Refraction: sphere +1.5 D, cylinder -1.75 D, axis 102°; age 66 — 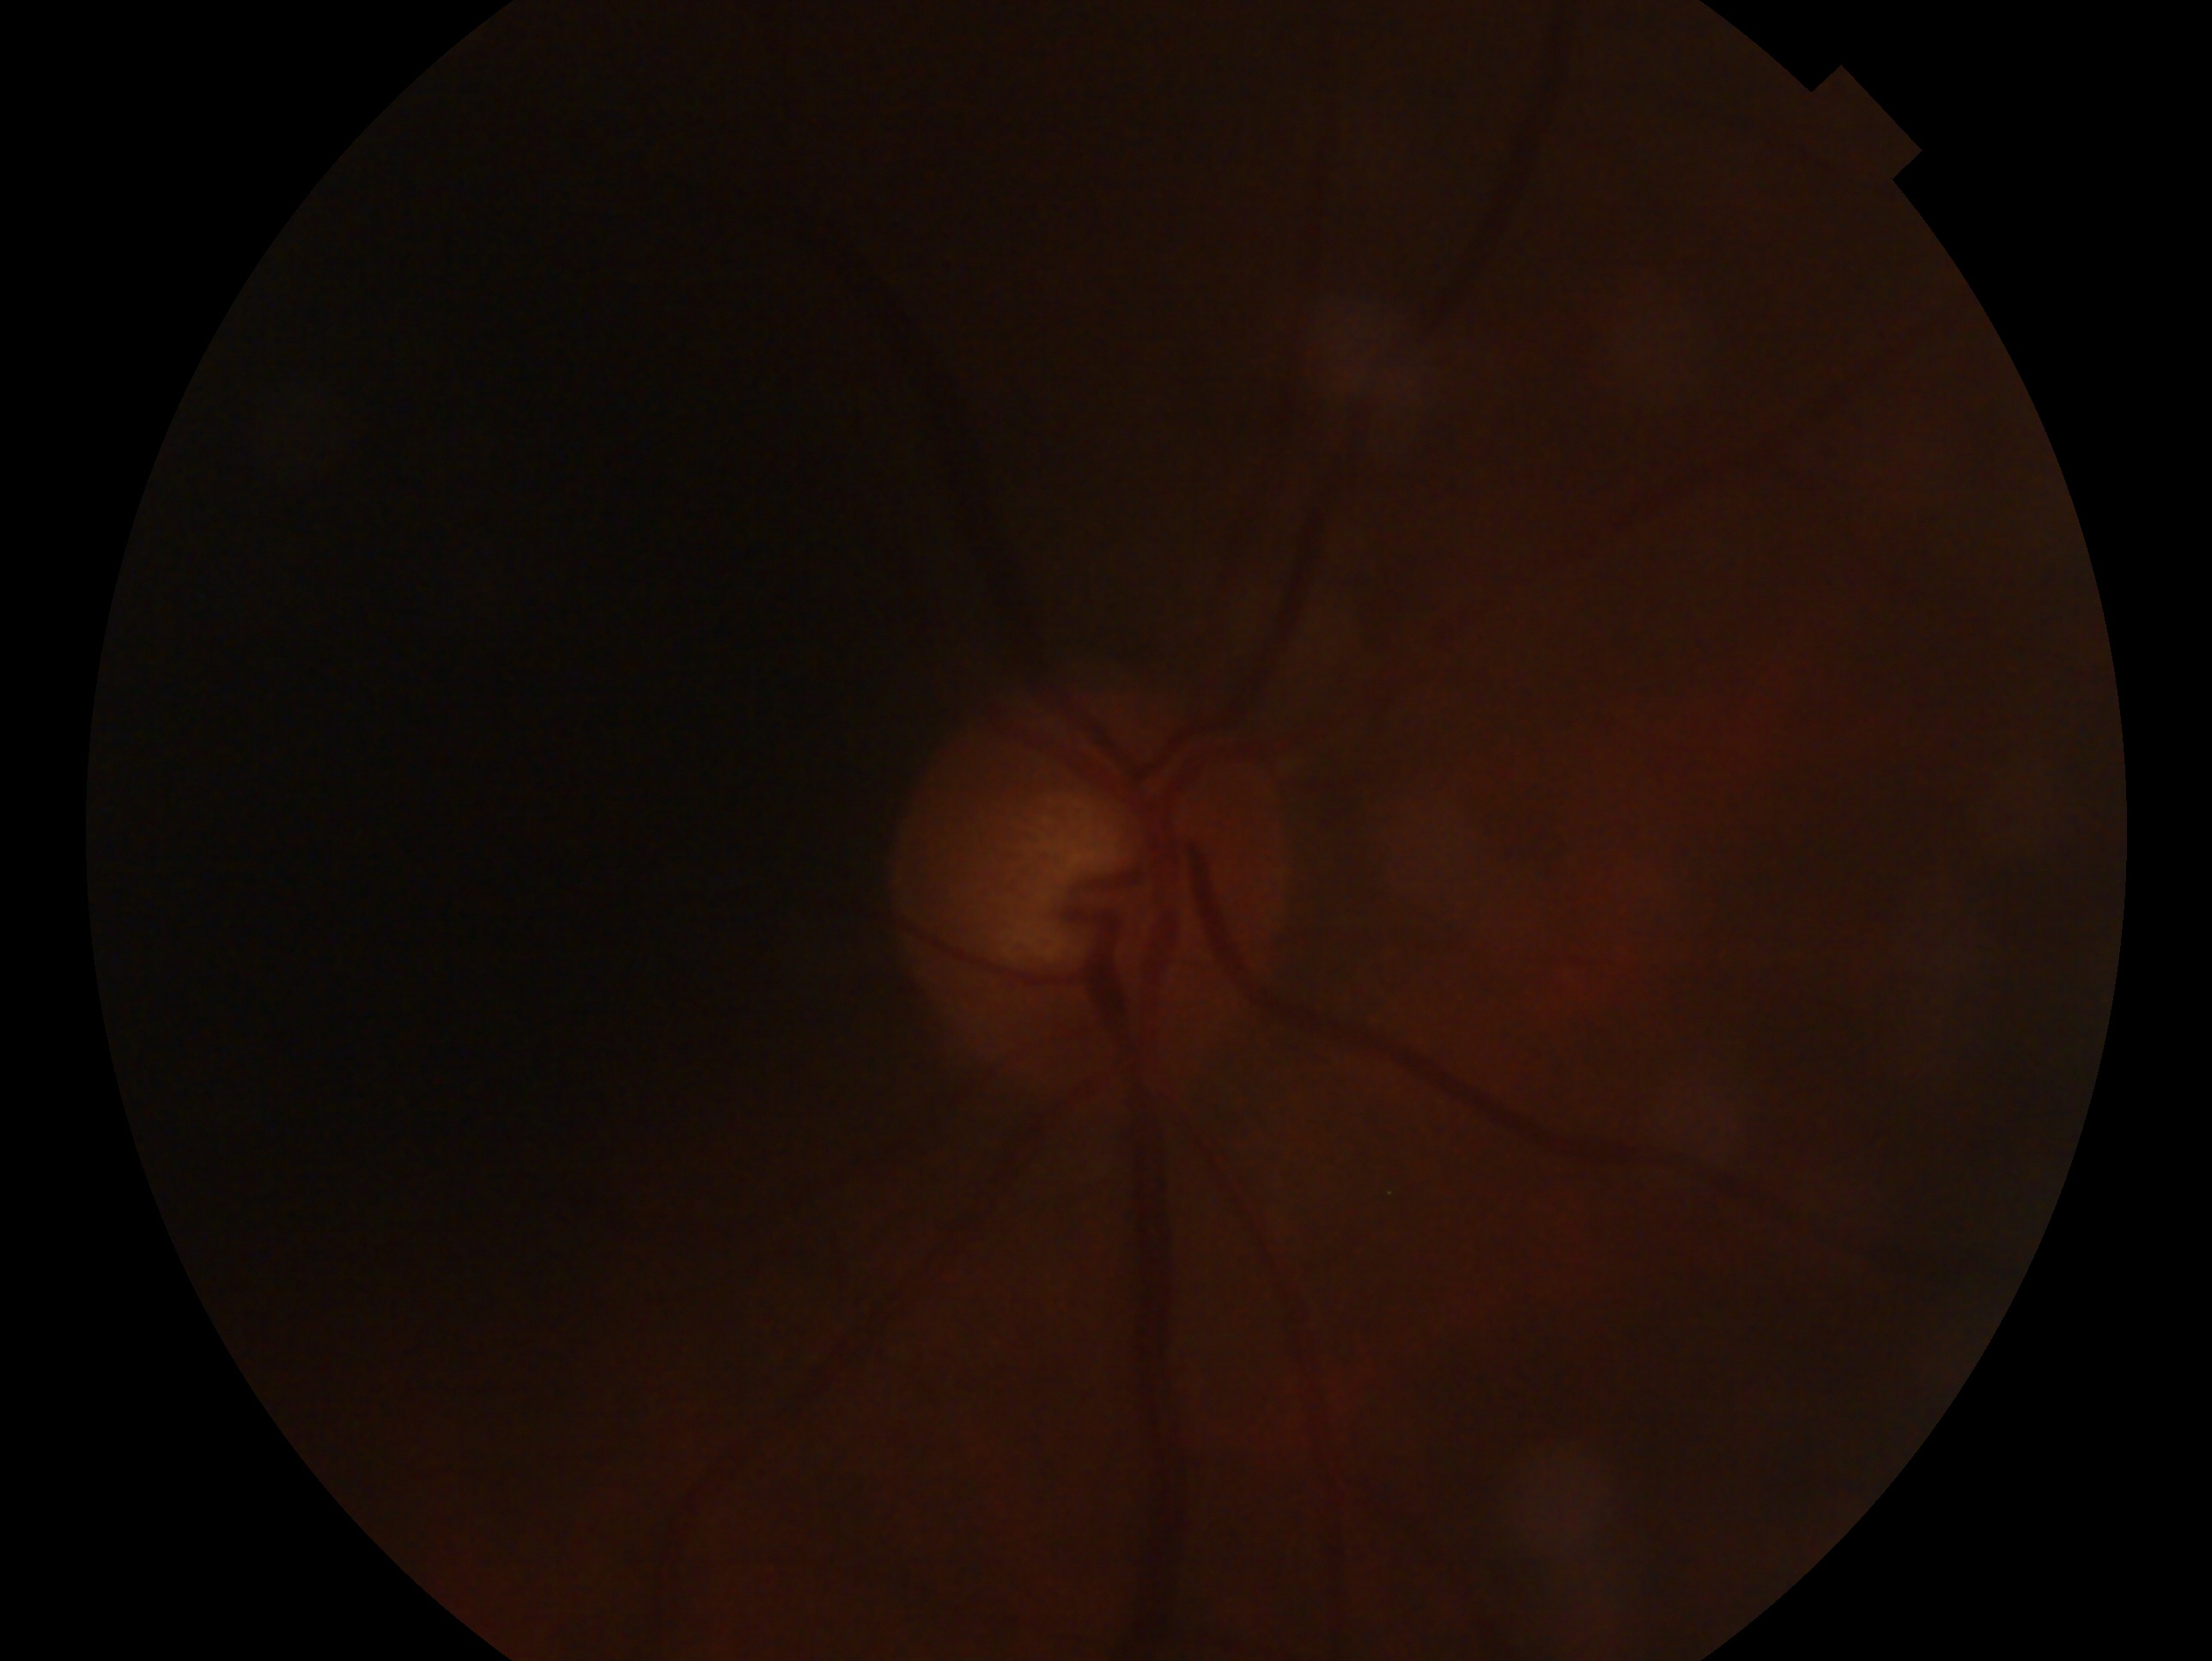   eye: oculus dexter
  glaucoma_dx: no glaucoma — no clinical evidence of glaucoma in this eye